640 x 480 pixels. Camera: Clarity RetCam 3 (130° FOV). Wide-field fundus photograph of an infant — 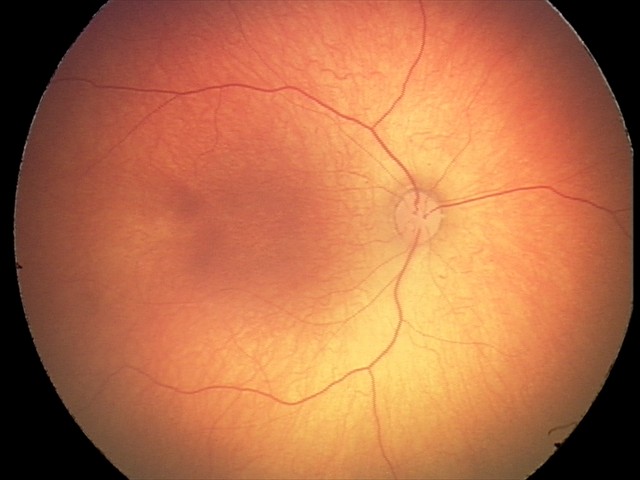 Physiological retinal appearance for postconceptual age.